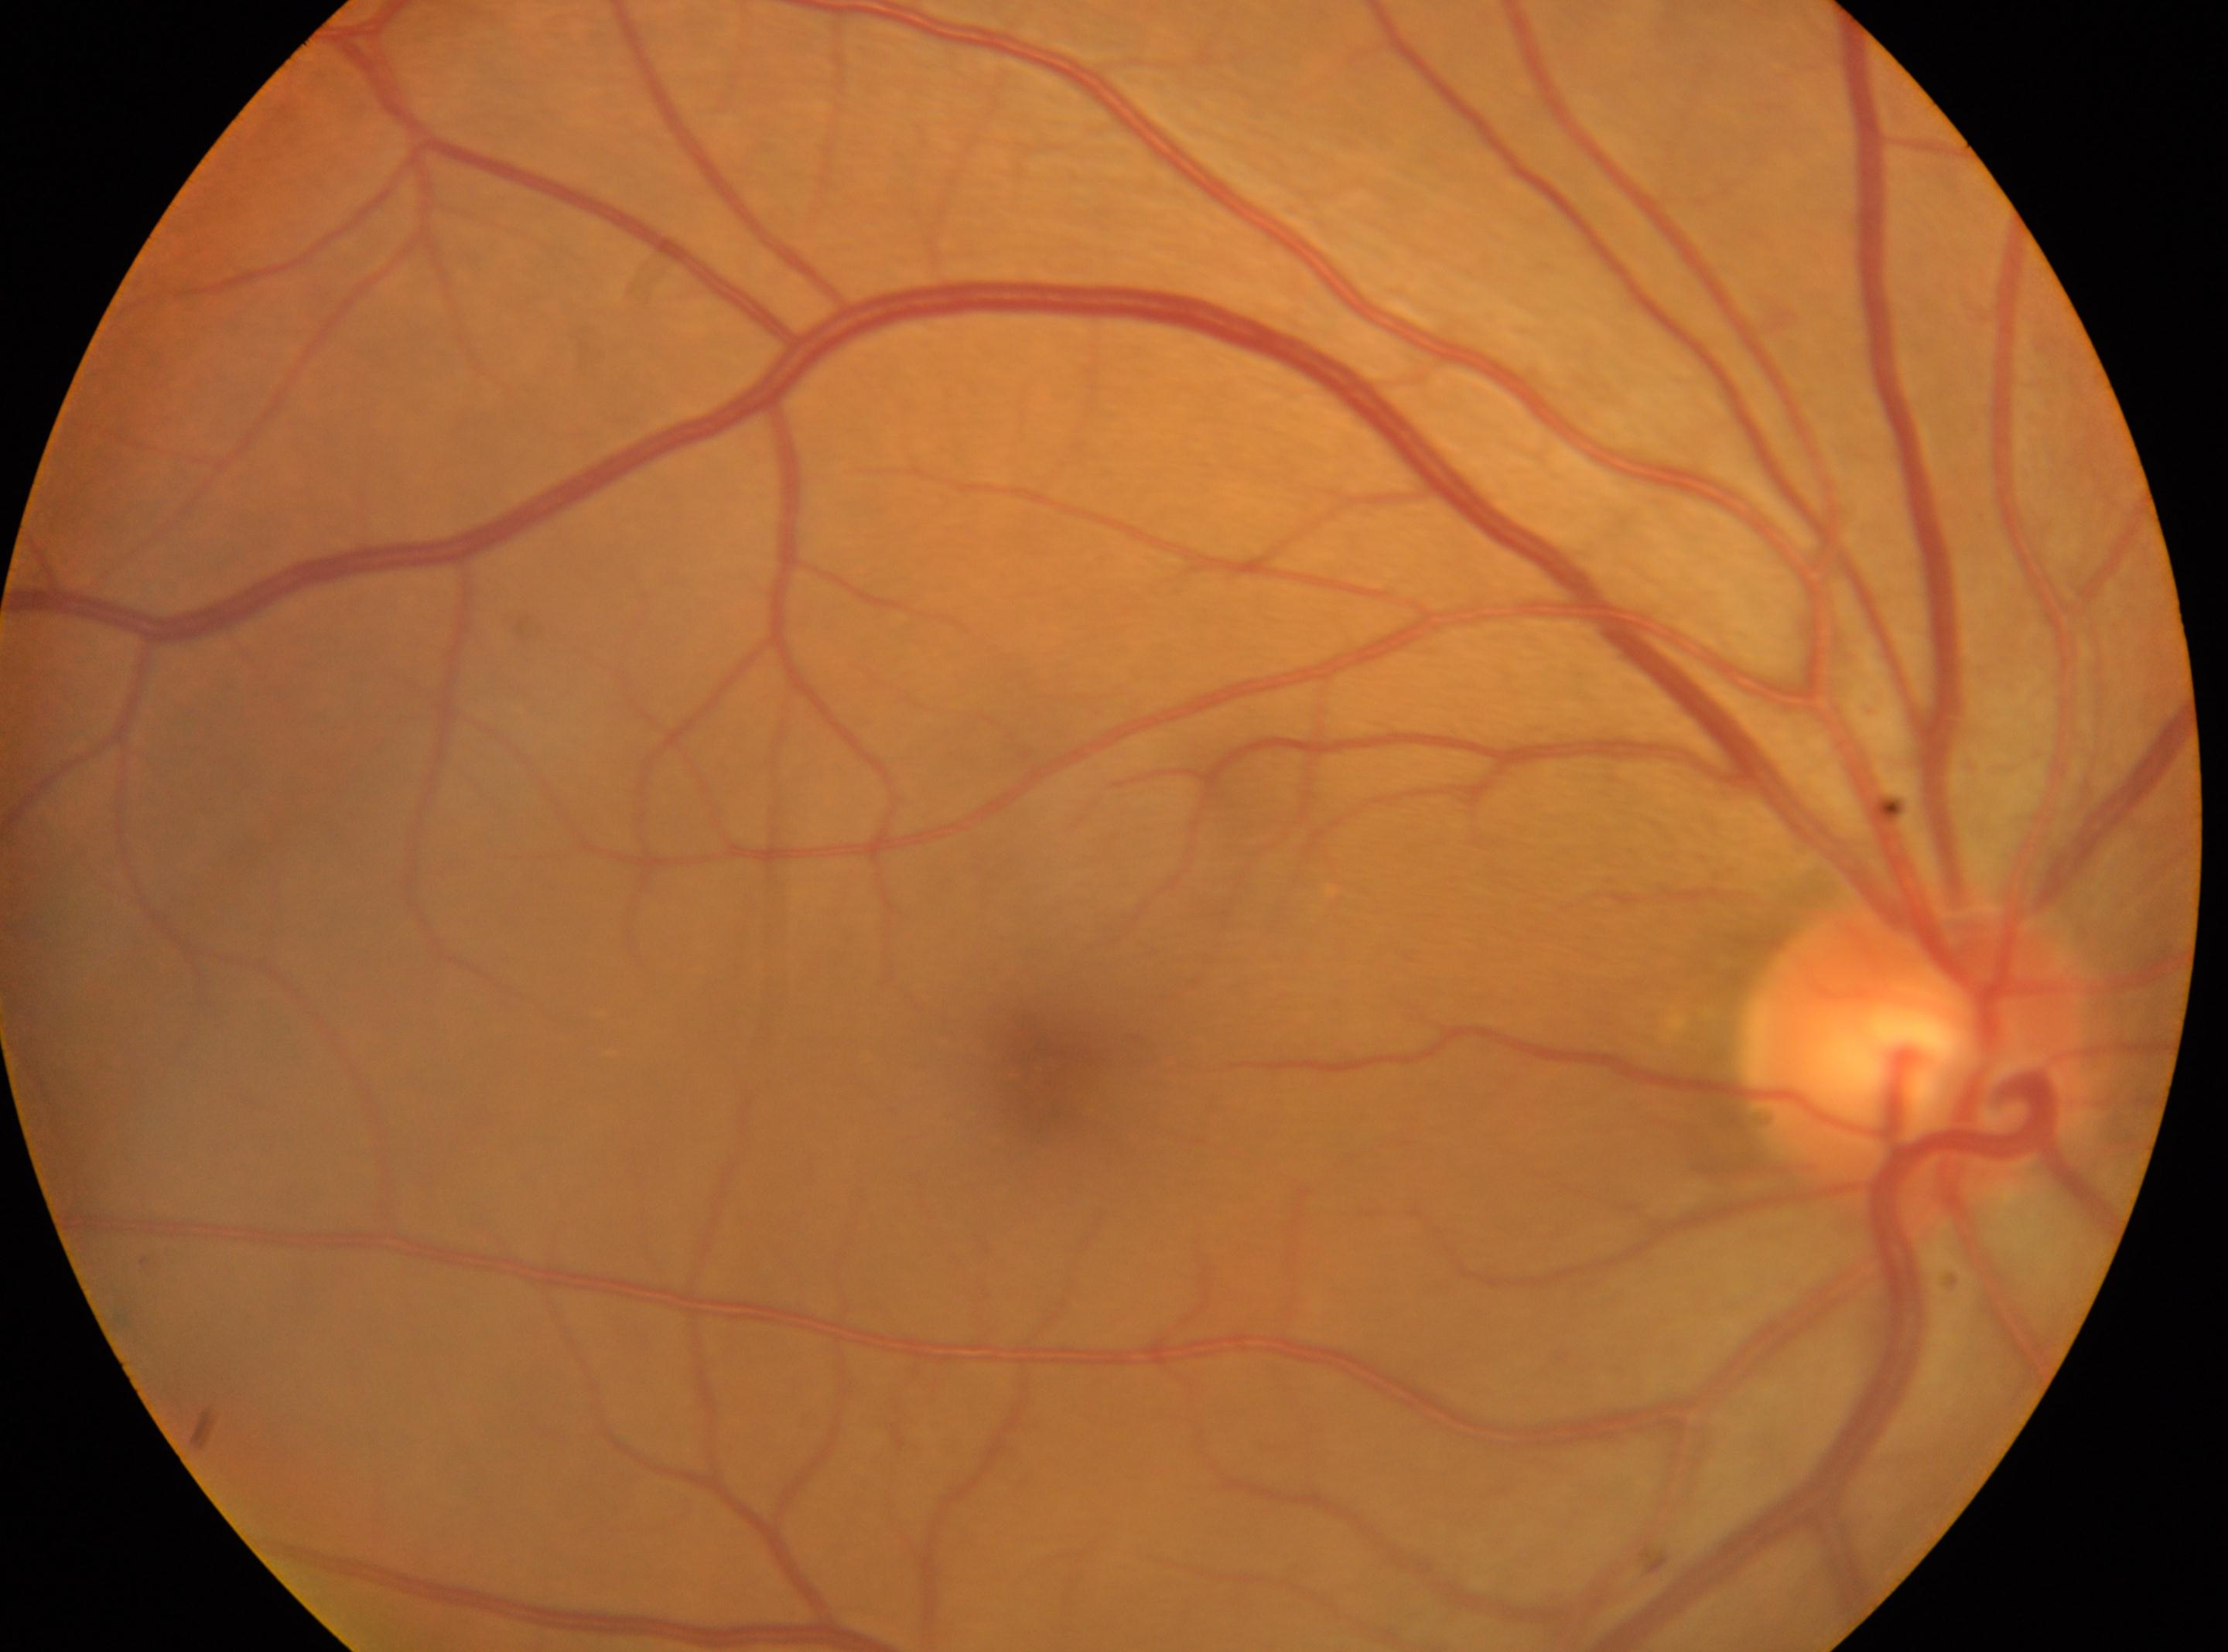

The optic disc is at (x: 1919, y: 1055). The macula center is at (x: 1037, y: 1073). DR grade is 0. Imaged eye: OD.